FOV: 45 degrees.
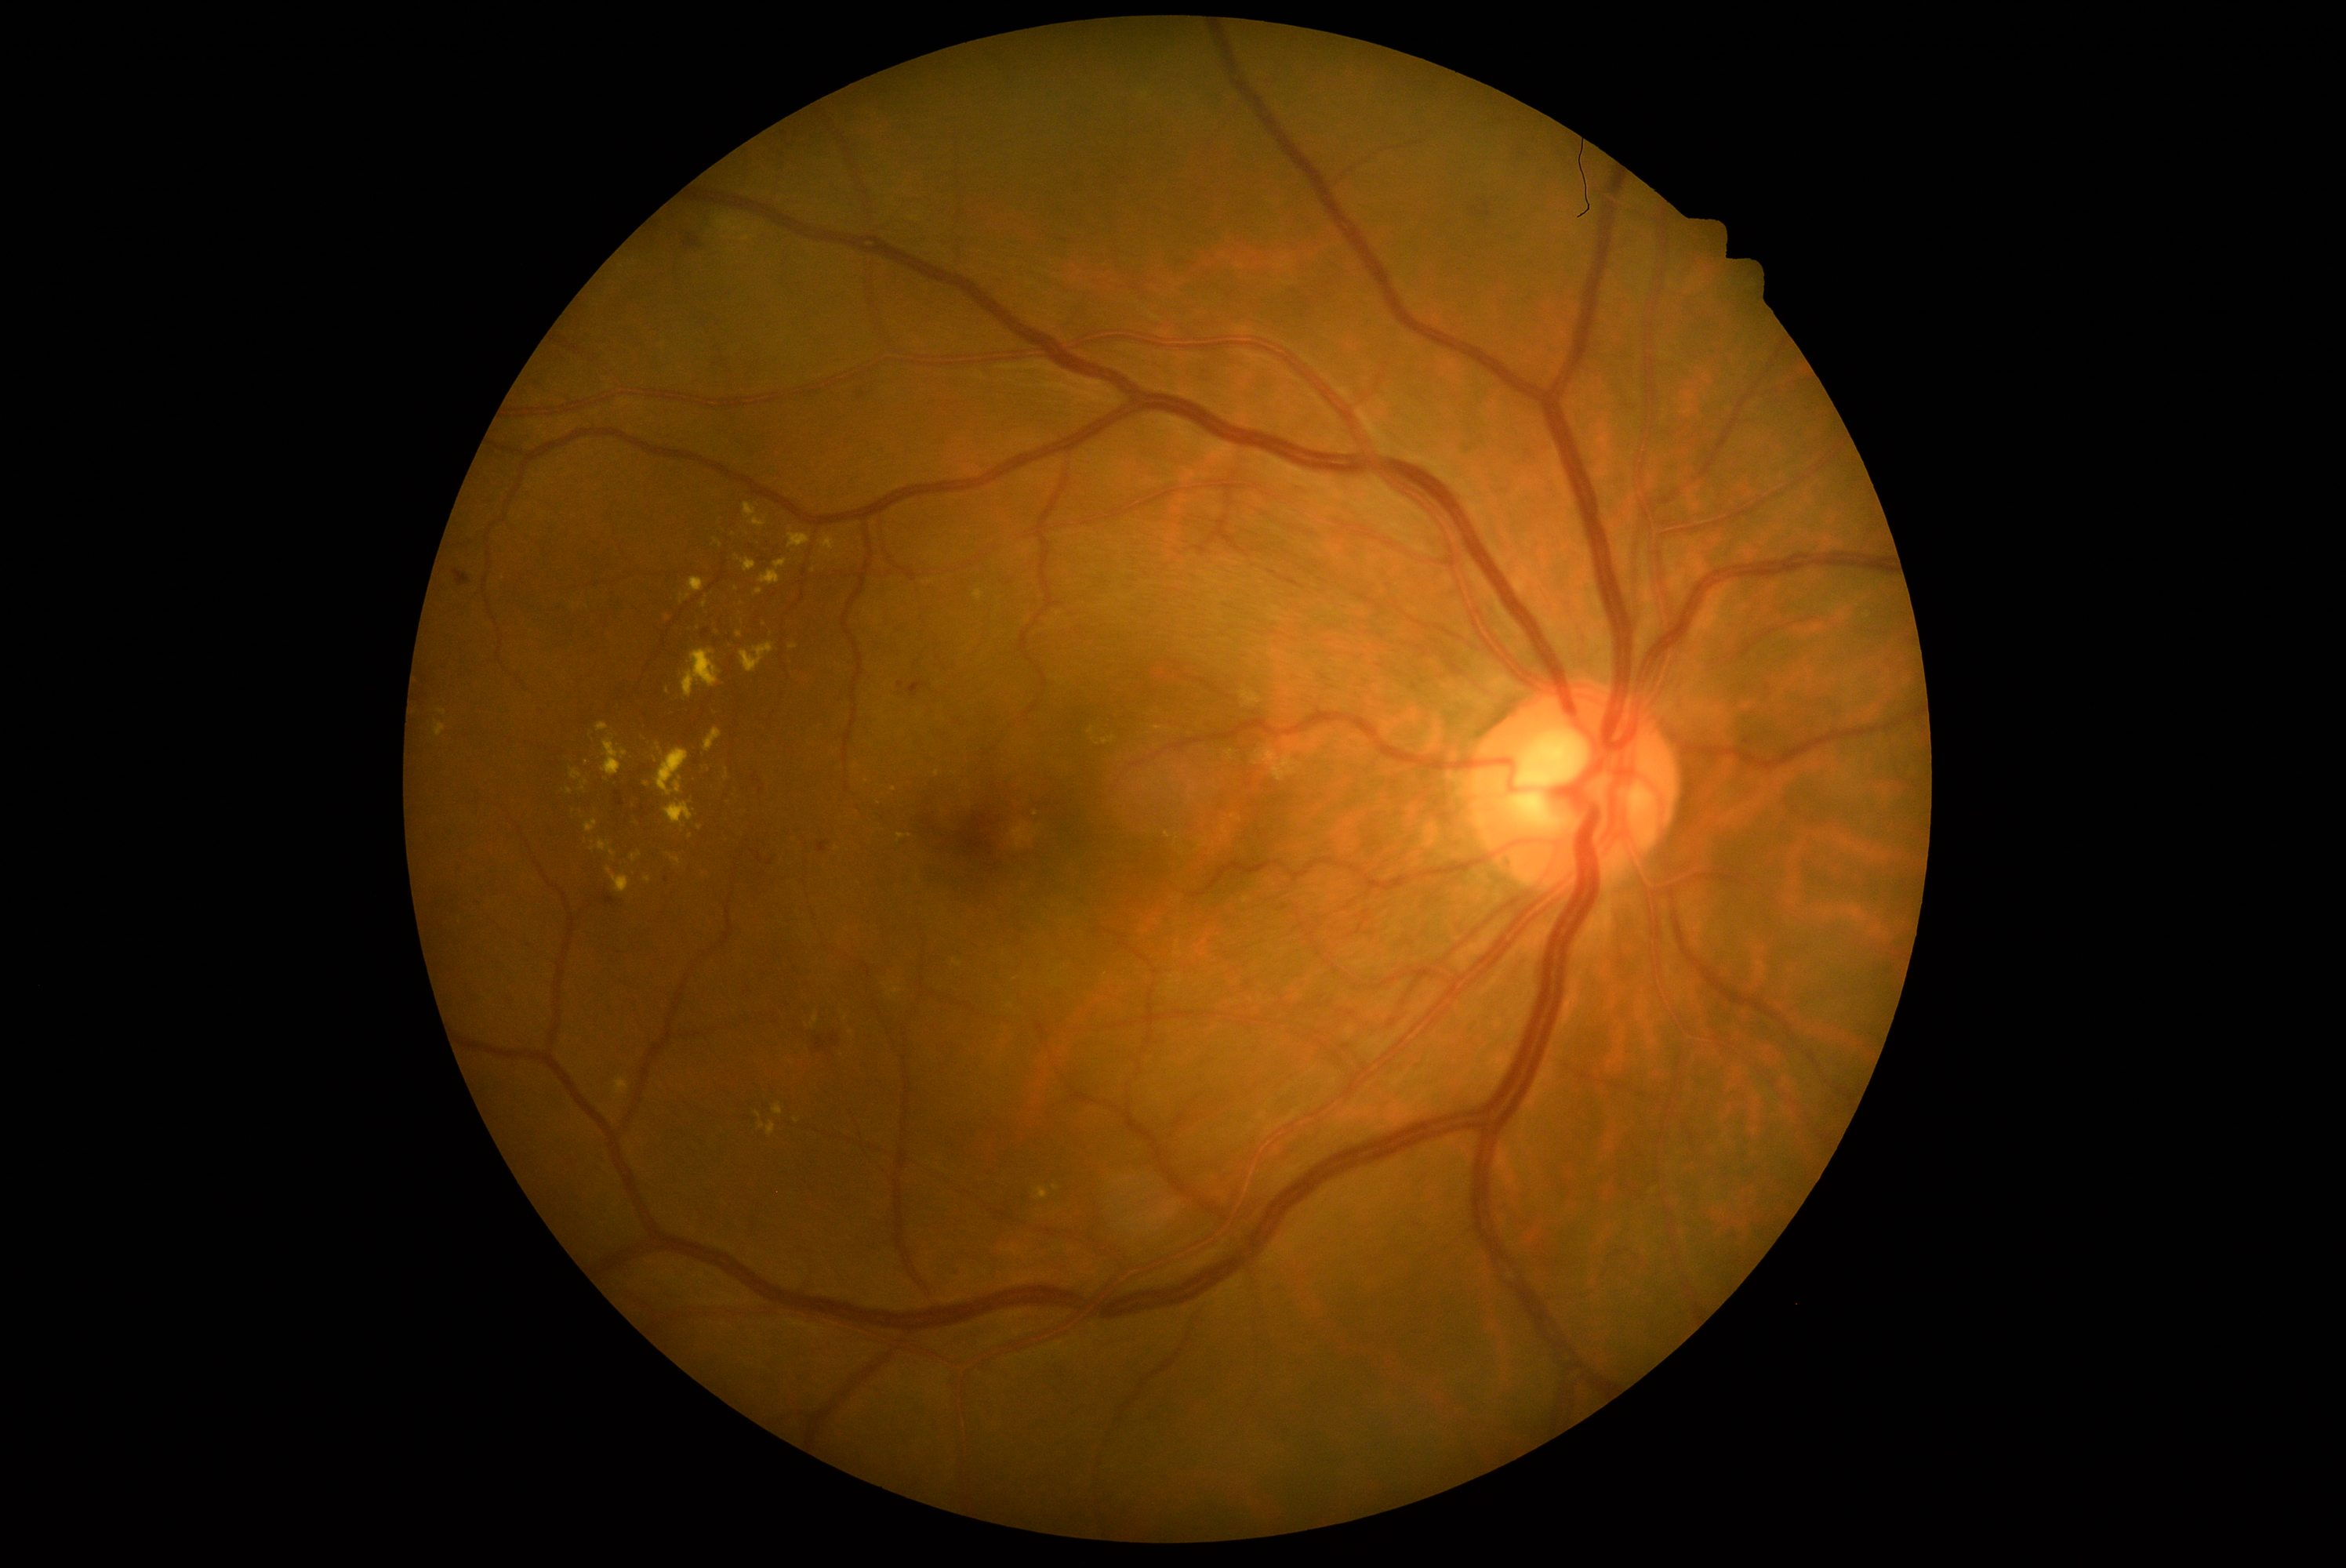 partial: true
dr_grade: 2
dr_grade_name: moderate NPDR
lesions:
  ex:
    - x1=644 y1=877 x2=652 y2=884
    - x1=631 y1=852 x2=642 y2=862
    - x1=760 y1=559 x2=788 y2=586
    - x1=898 y1=833 x2=906 y2=841
    - x1=769 y1=631 x2=772 y2=639
    - x1=973 y1=590 x2=984 y2=601
    - x1=655 y1=749 x2=689 y2=797
    - x1=435 y1=722 x2=446 y2=736
    - x1=703 y1=598 x2=708 y2=608
    - x1=616 y1=1080 x2=630 y2=1095
    - x1=738 y1=598 x2=743 y2=606
    - x1=705 y1=728 x2=722 y2=753
    - x1=672 y1=858 x2=681 y2=866
  ex_small_centers:
    - [910,836]
    - [1055,1188]
    - [894,790]